Pediatric retinal photograph (wide-field). 1240 by 1240 pixels. Captured with the Phoenix ICON (100° field of view) — 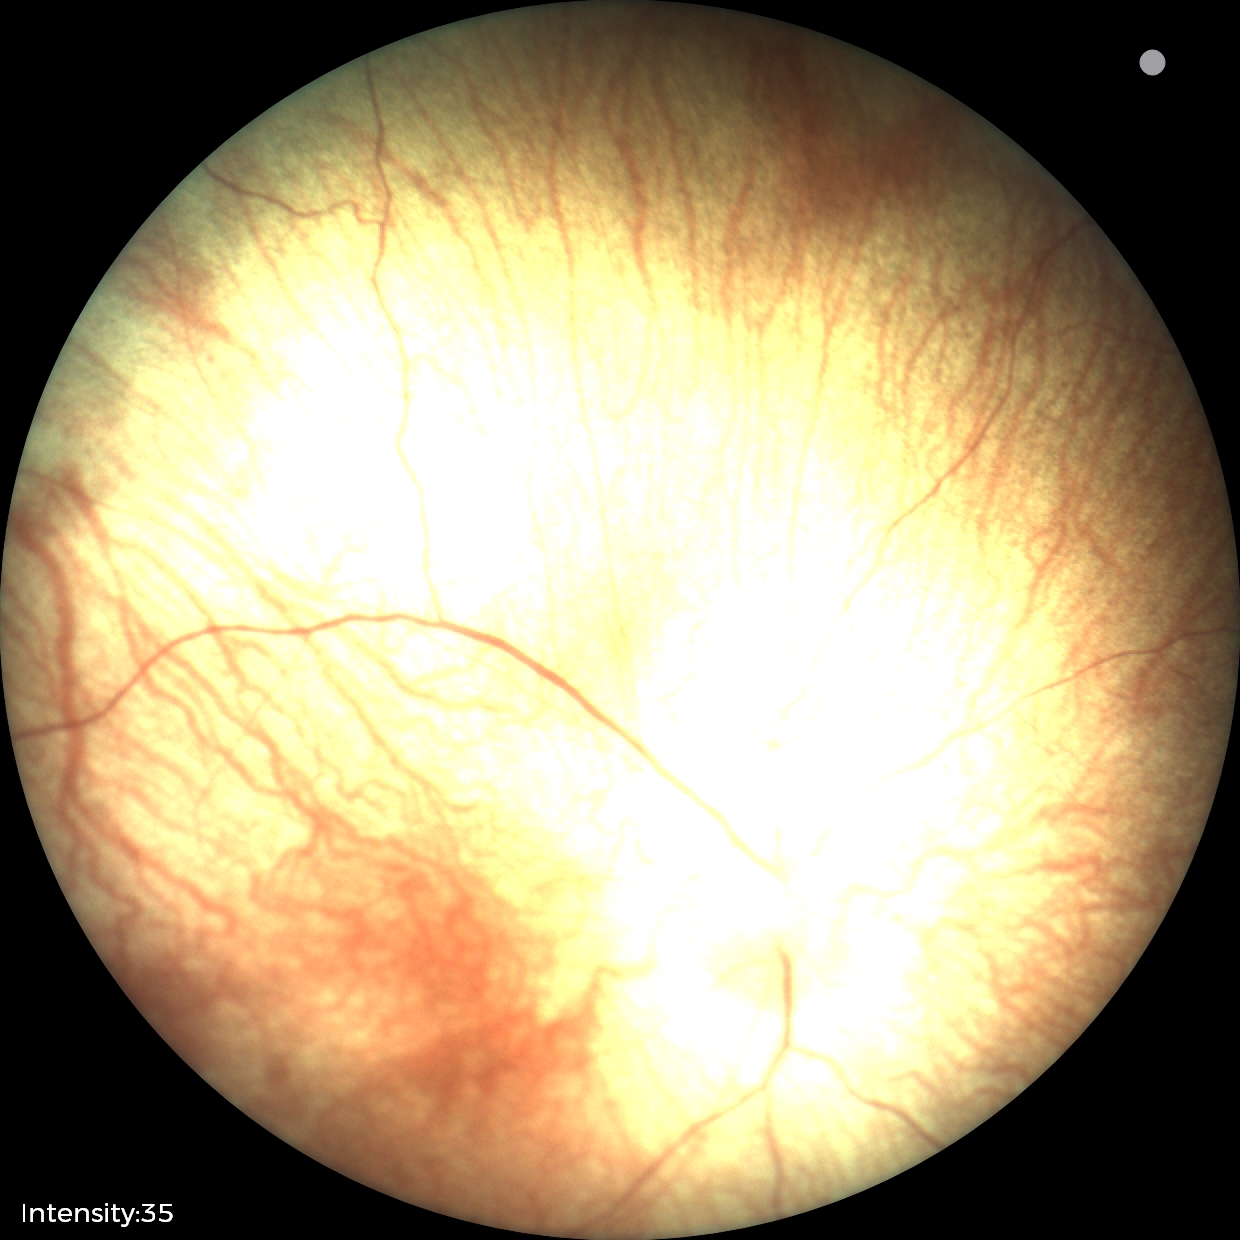

Normal screening examination.